Color fundus image
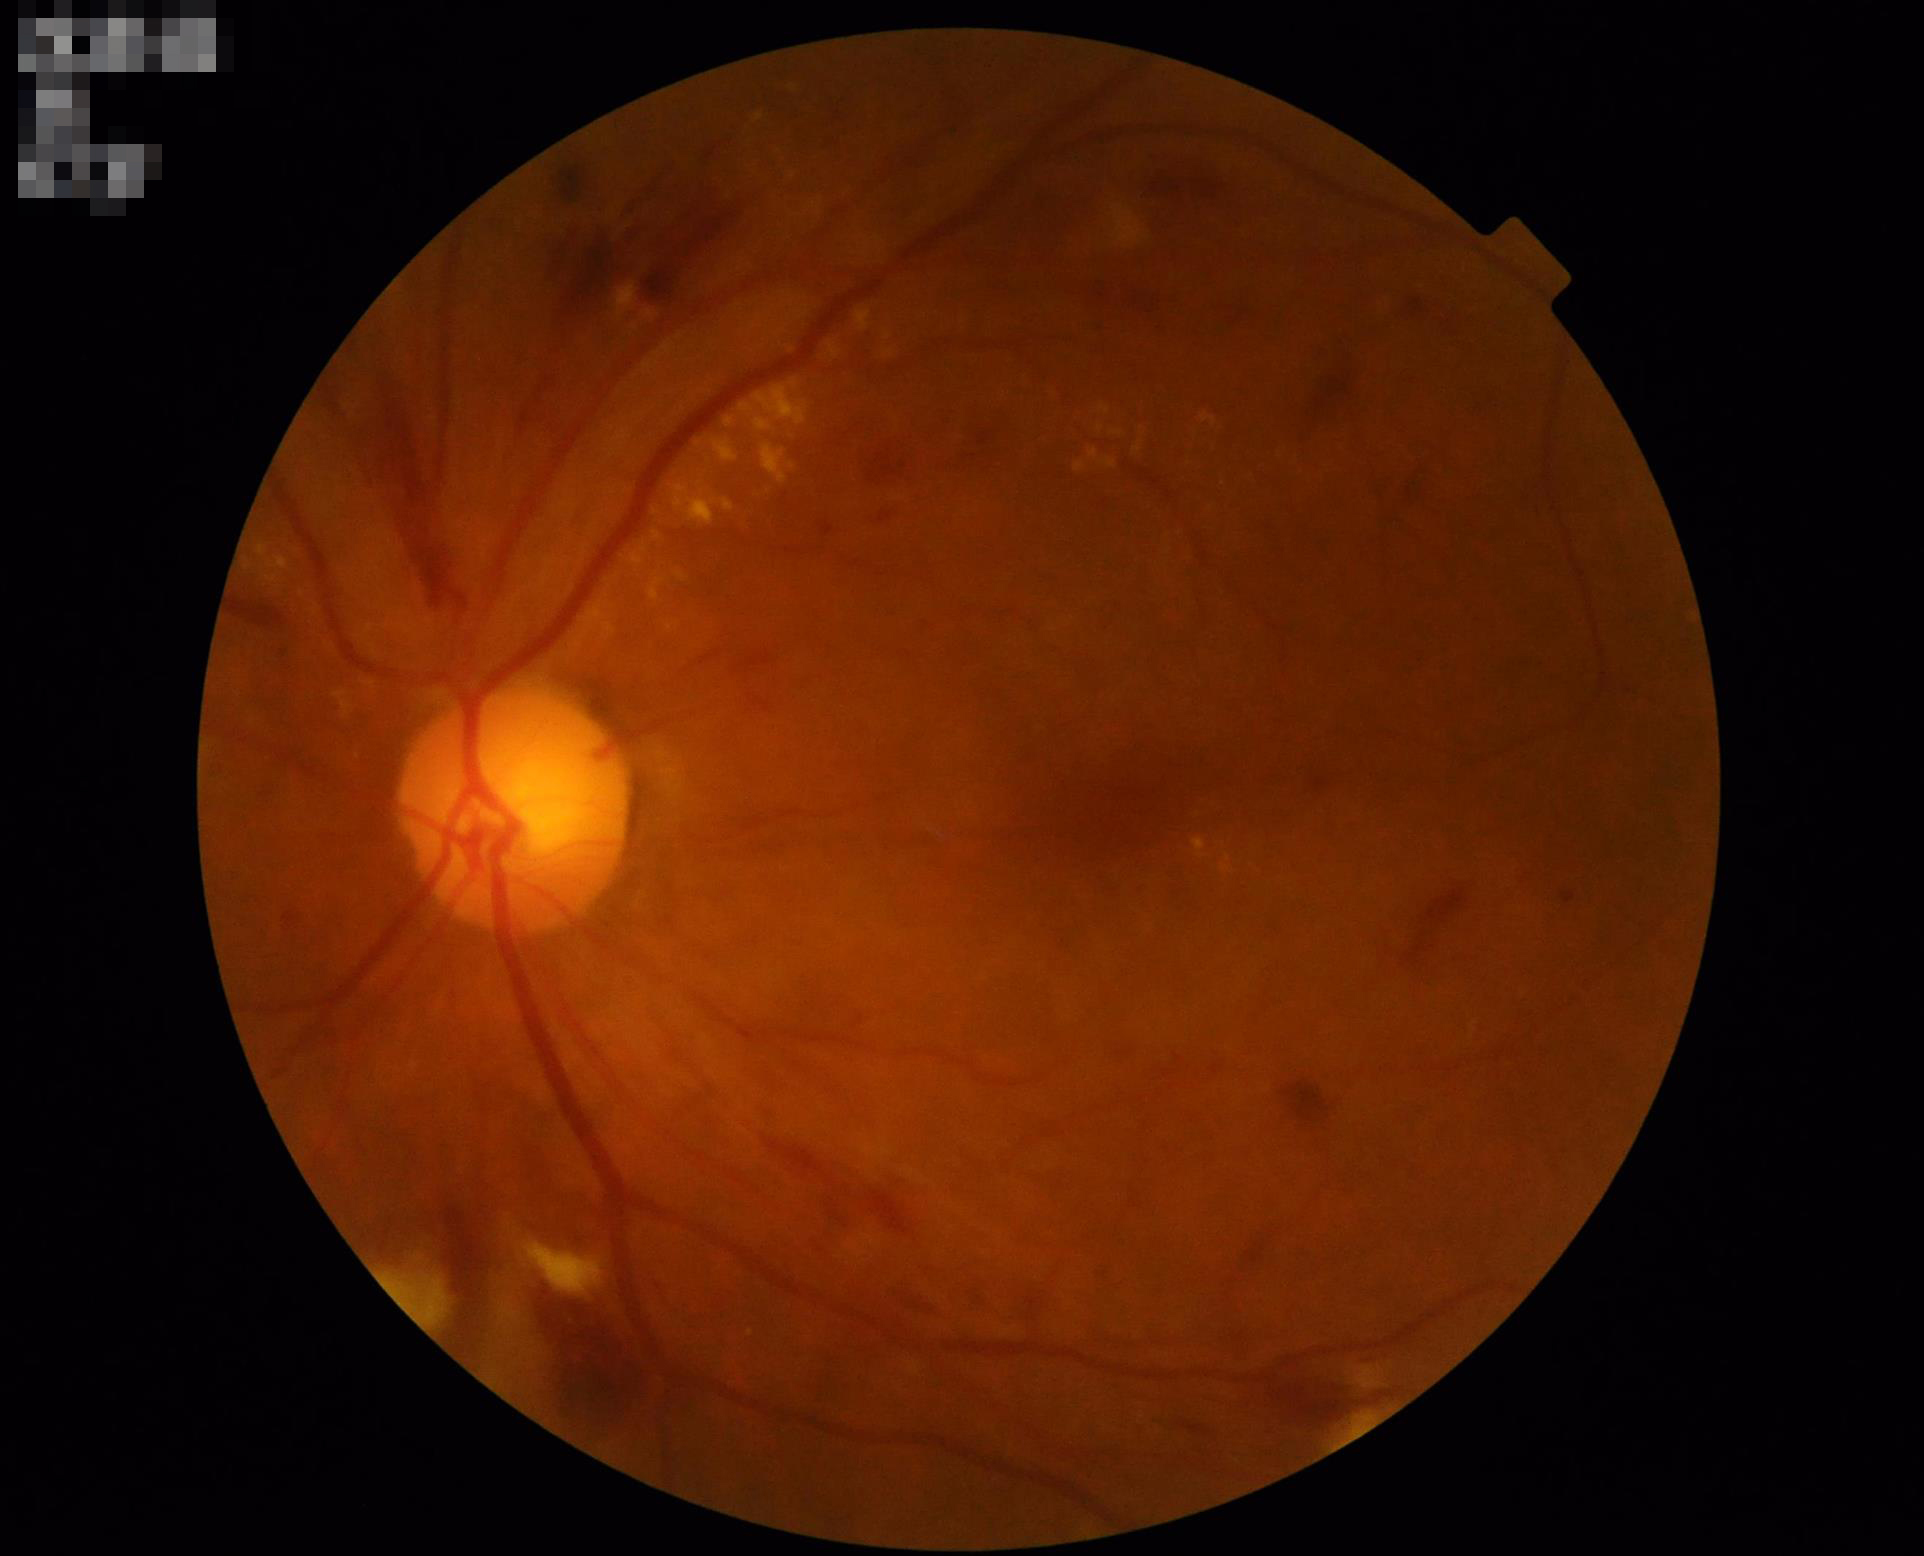
Quality grading: focus: clear | overall: adequate.